1923 by 1932 pixels: 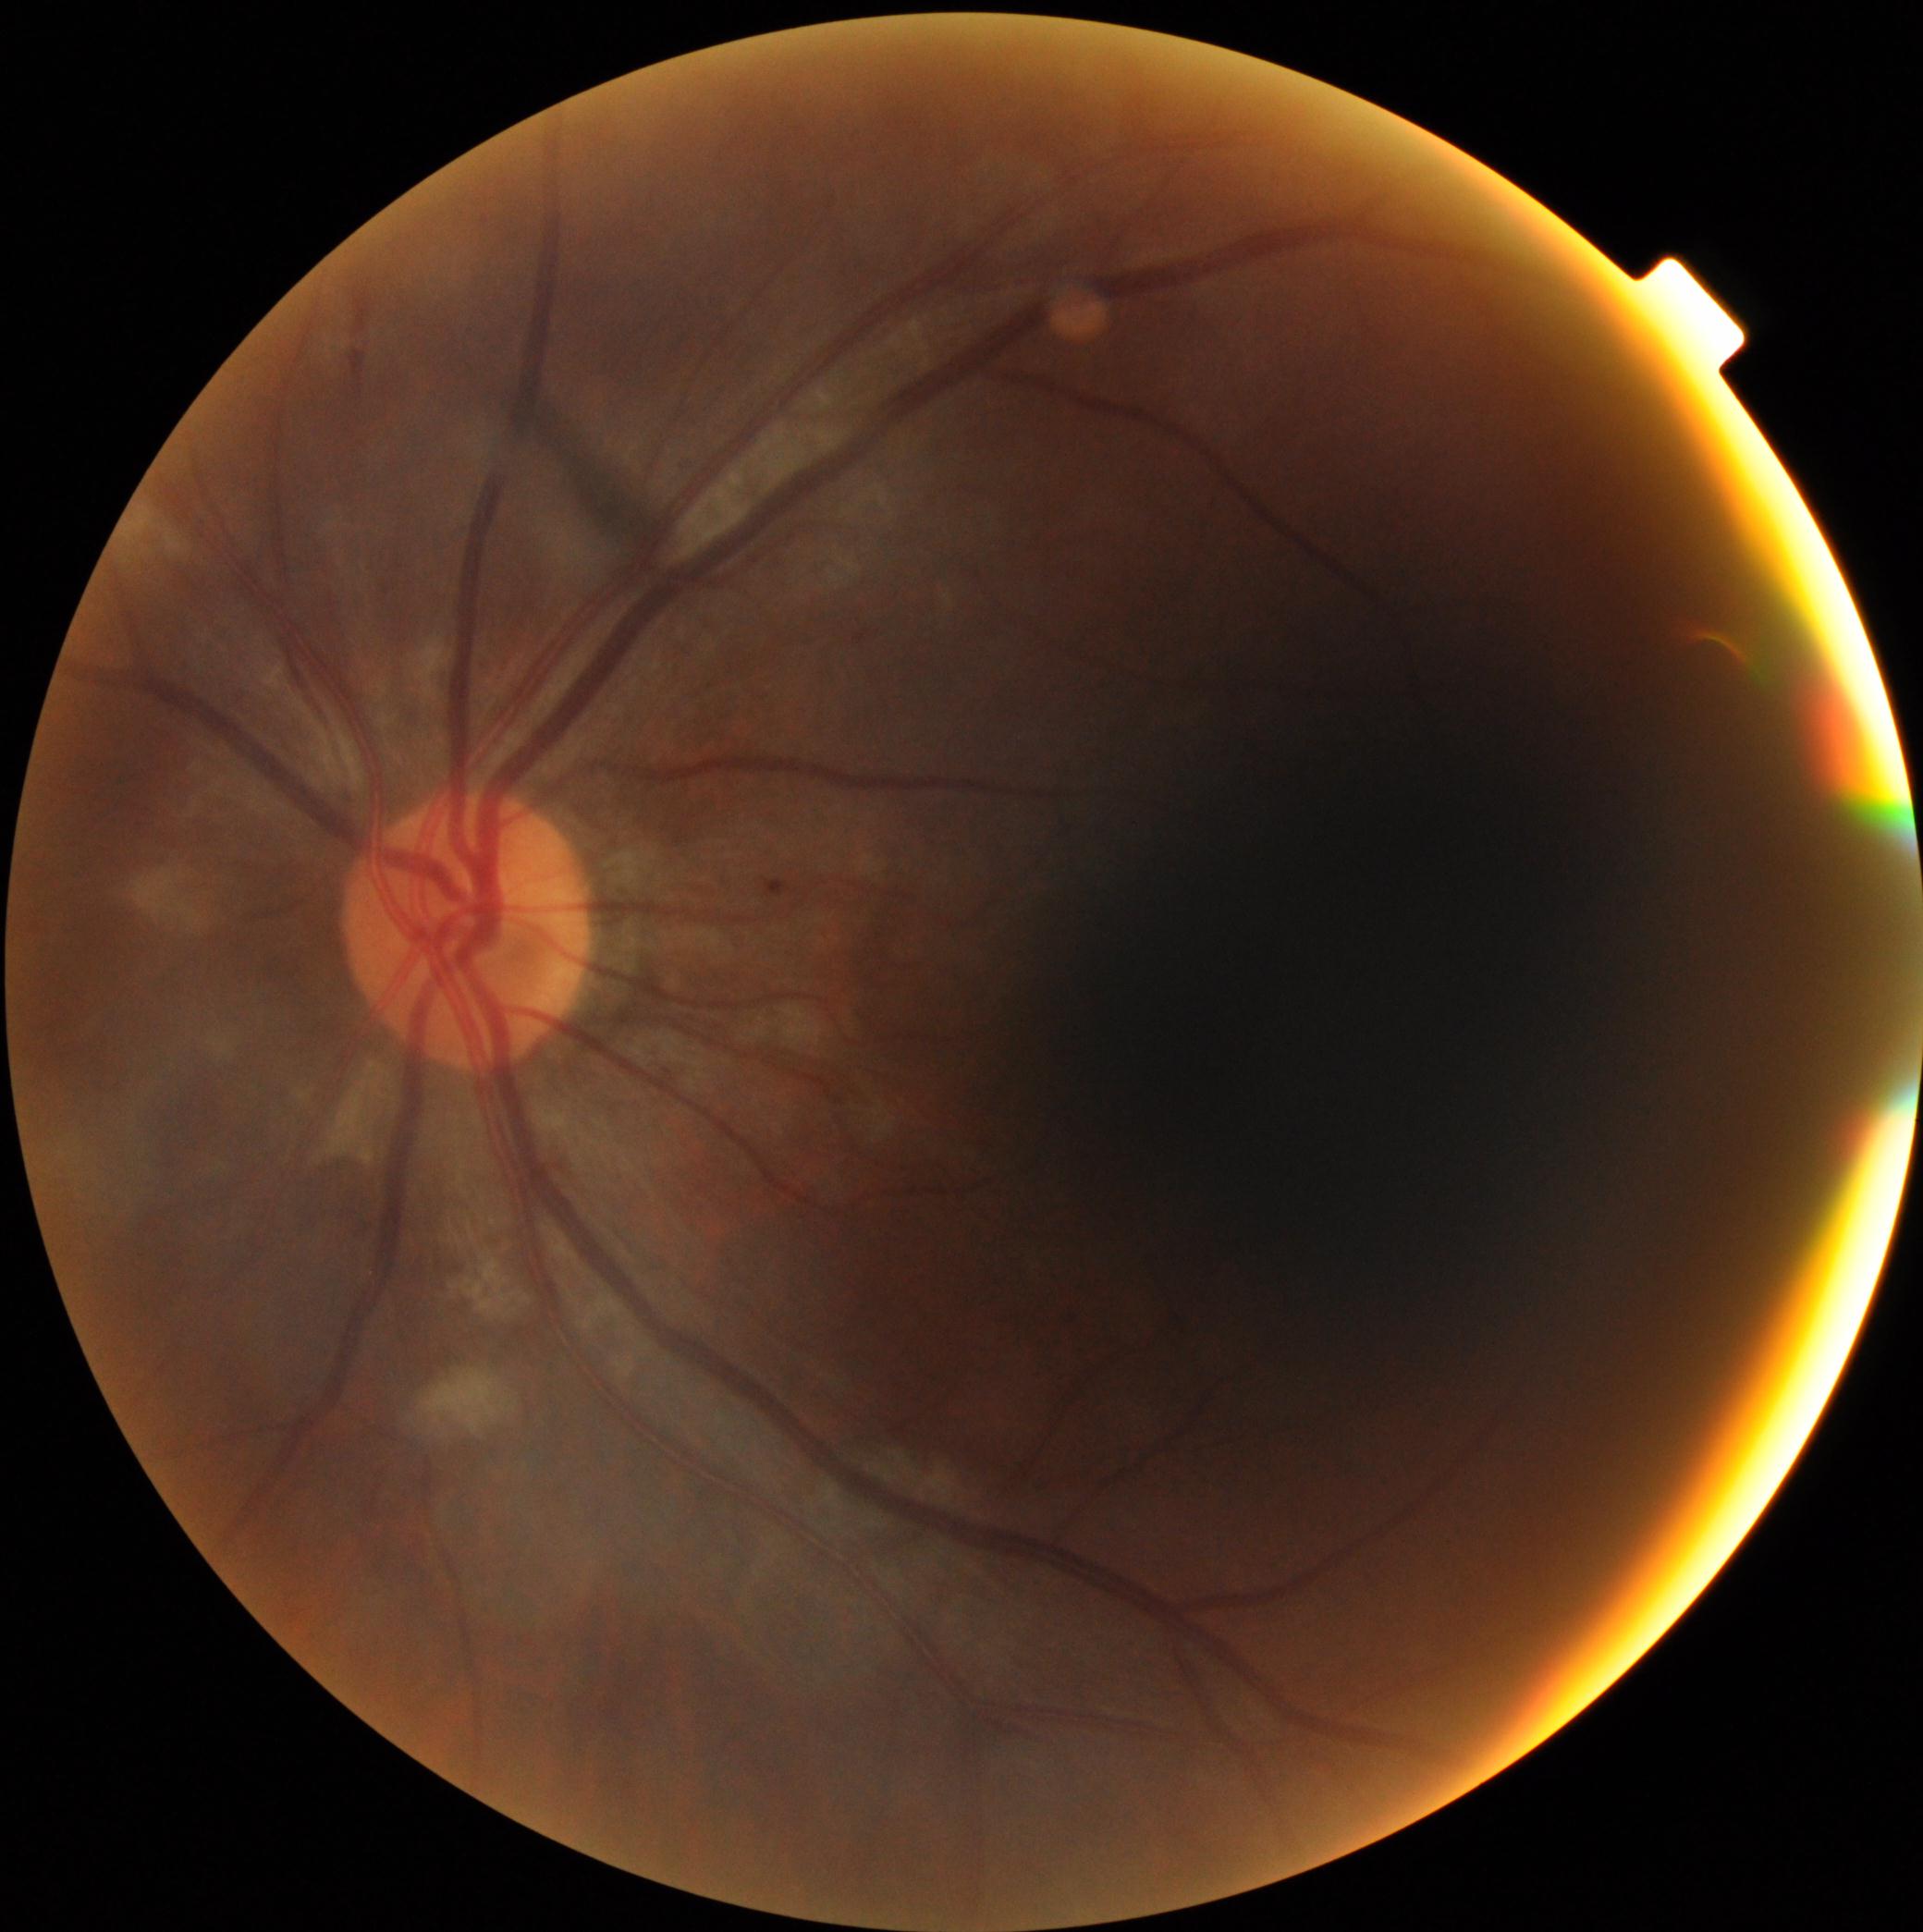 DR grade is 2 (moderate NPDR).